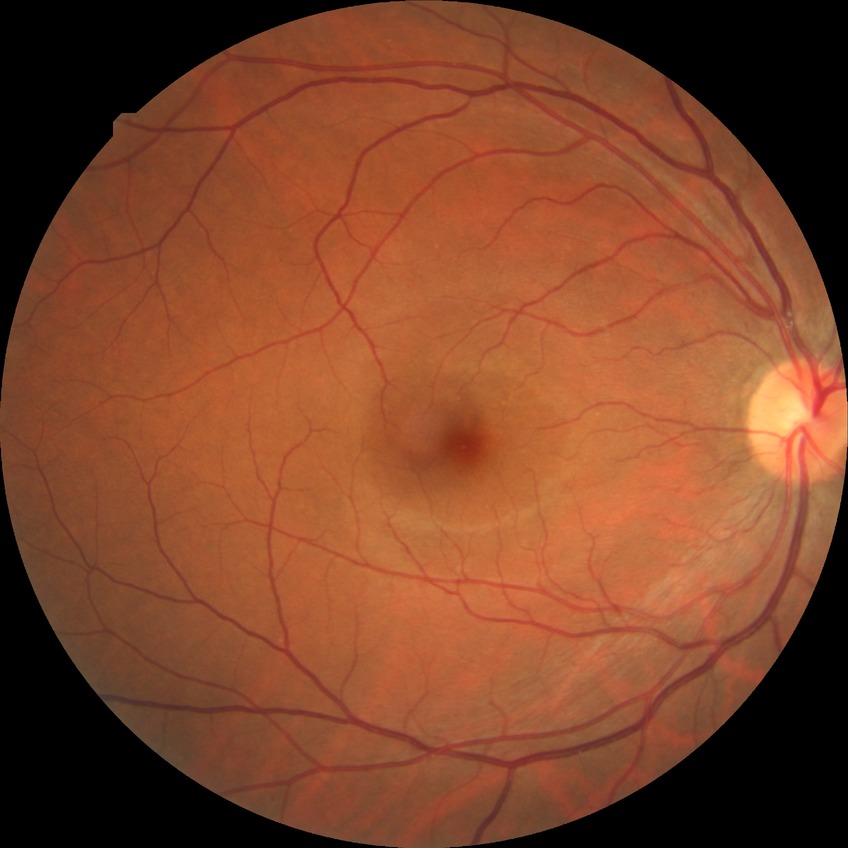

diabetic retinopathy (DR)@NDR (no diabetic retinopathy).